Color fundus image · 45° field of view · 2346 by 1568 pixels
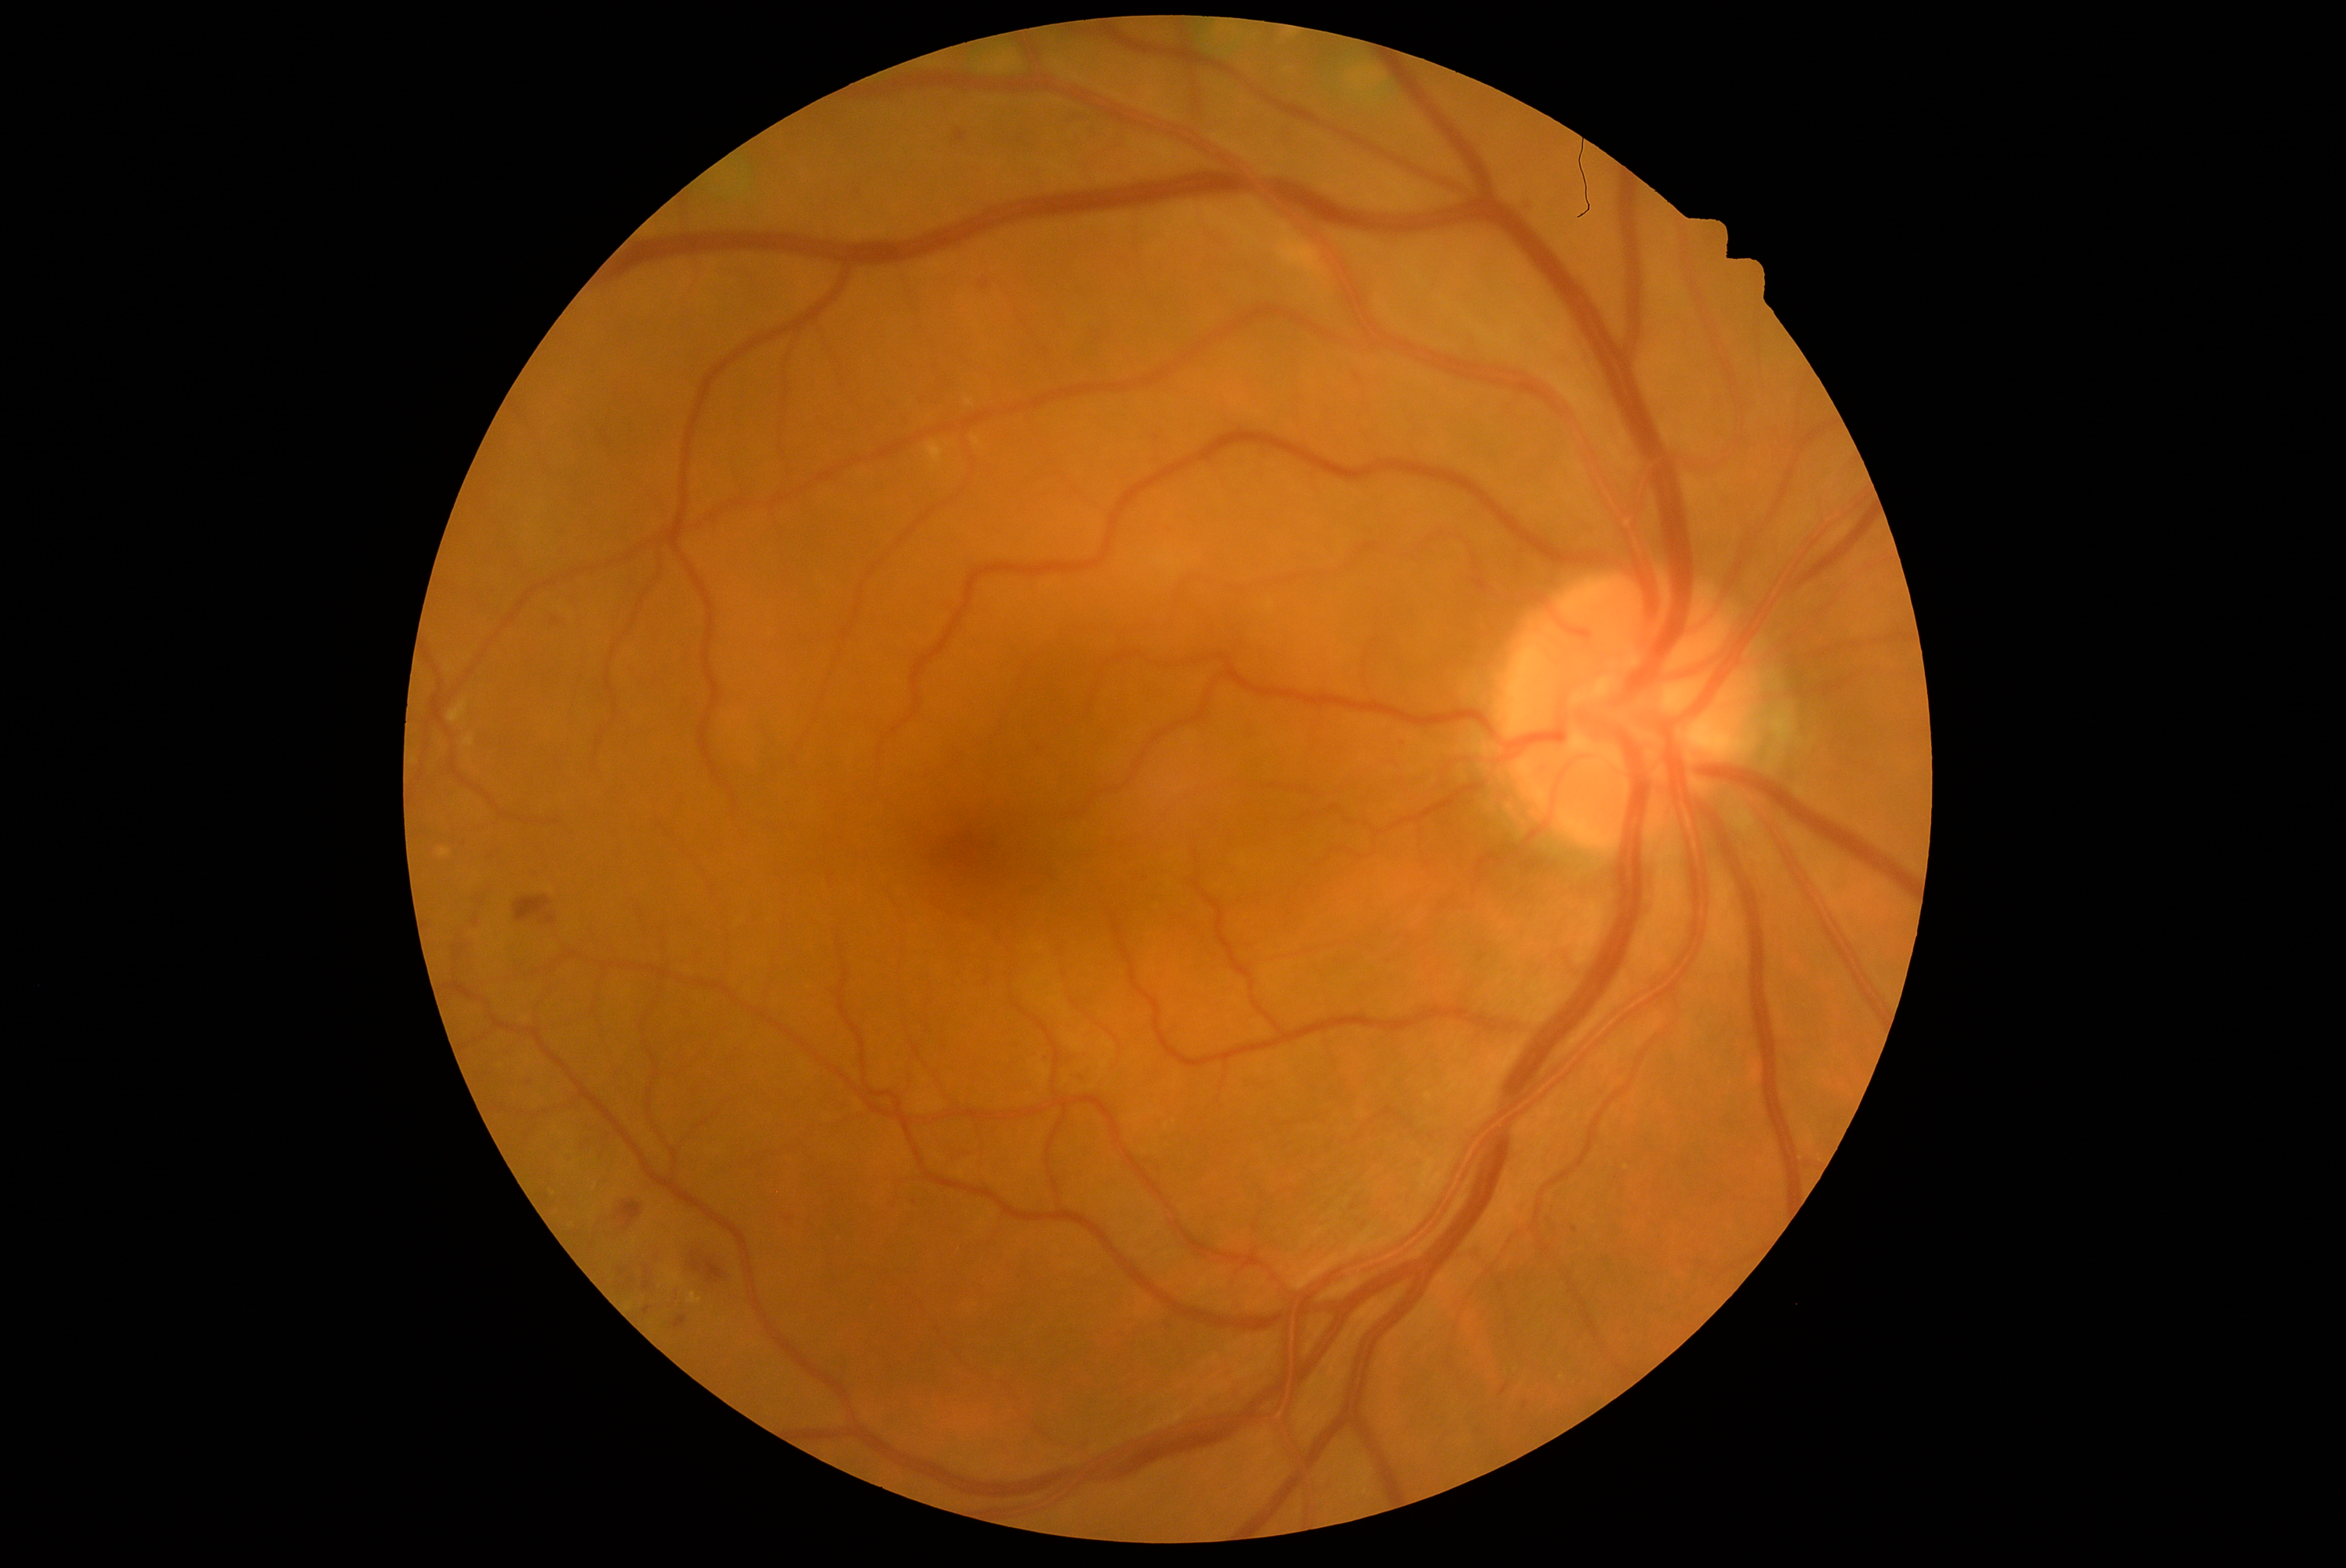

Diabetic retinopathy (DR) is grade 2; non-proliferative diabetic retinopathy
Lesions identified (partial list):
- soft exudates (SEs): none identified
- hard exudates (EXs): (689, 1293, 702, 1304), (928, 443, 943, 463), (449, 702, 468, 724), (973, 437, 981, 448), (967, 399, 975, 407), (465, 736, 474, 747), (672, 1272, 681, 1287)
- Small EXs near Point(668, 1283), Point(554, 1194), Point(596, 1187), Point(635, 1240)
- hemorrhages (HEs): (685, 1244, 732, 1299), (515, 896, 551, 923), (551, 611, 567, 630), (617, 1200, 642, 1229)
- microaneurysms (MAs) (continued): (528, 1076, 537, 1086), (1500, 1385, 1509, 1396), (644, 1282, 650, 1290), (1078, 1073, 1086, 1089), (568, 1153, 575, 1163), (1520, 1399, 1528, 1410), (674, 1316, 686, 1329)
- Small MAs near Point(789, 1220), Point(1047, 1061), Point(491, 856), Point(1574, 1231)